2352x1568px. Fundus photo. 45° field of view
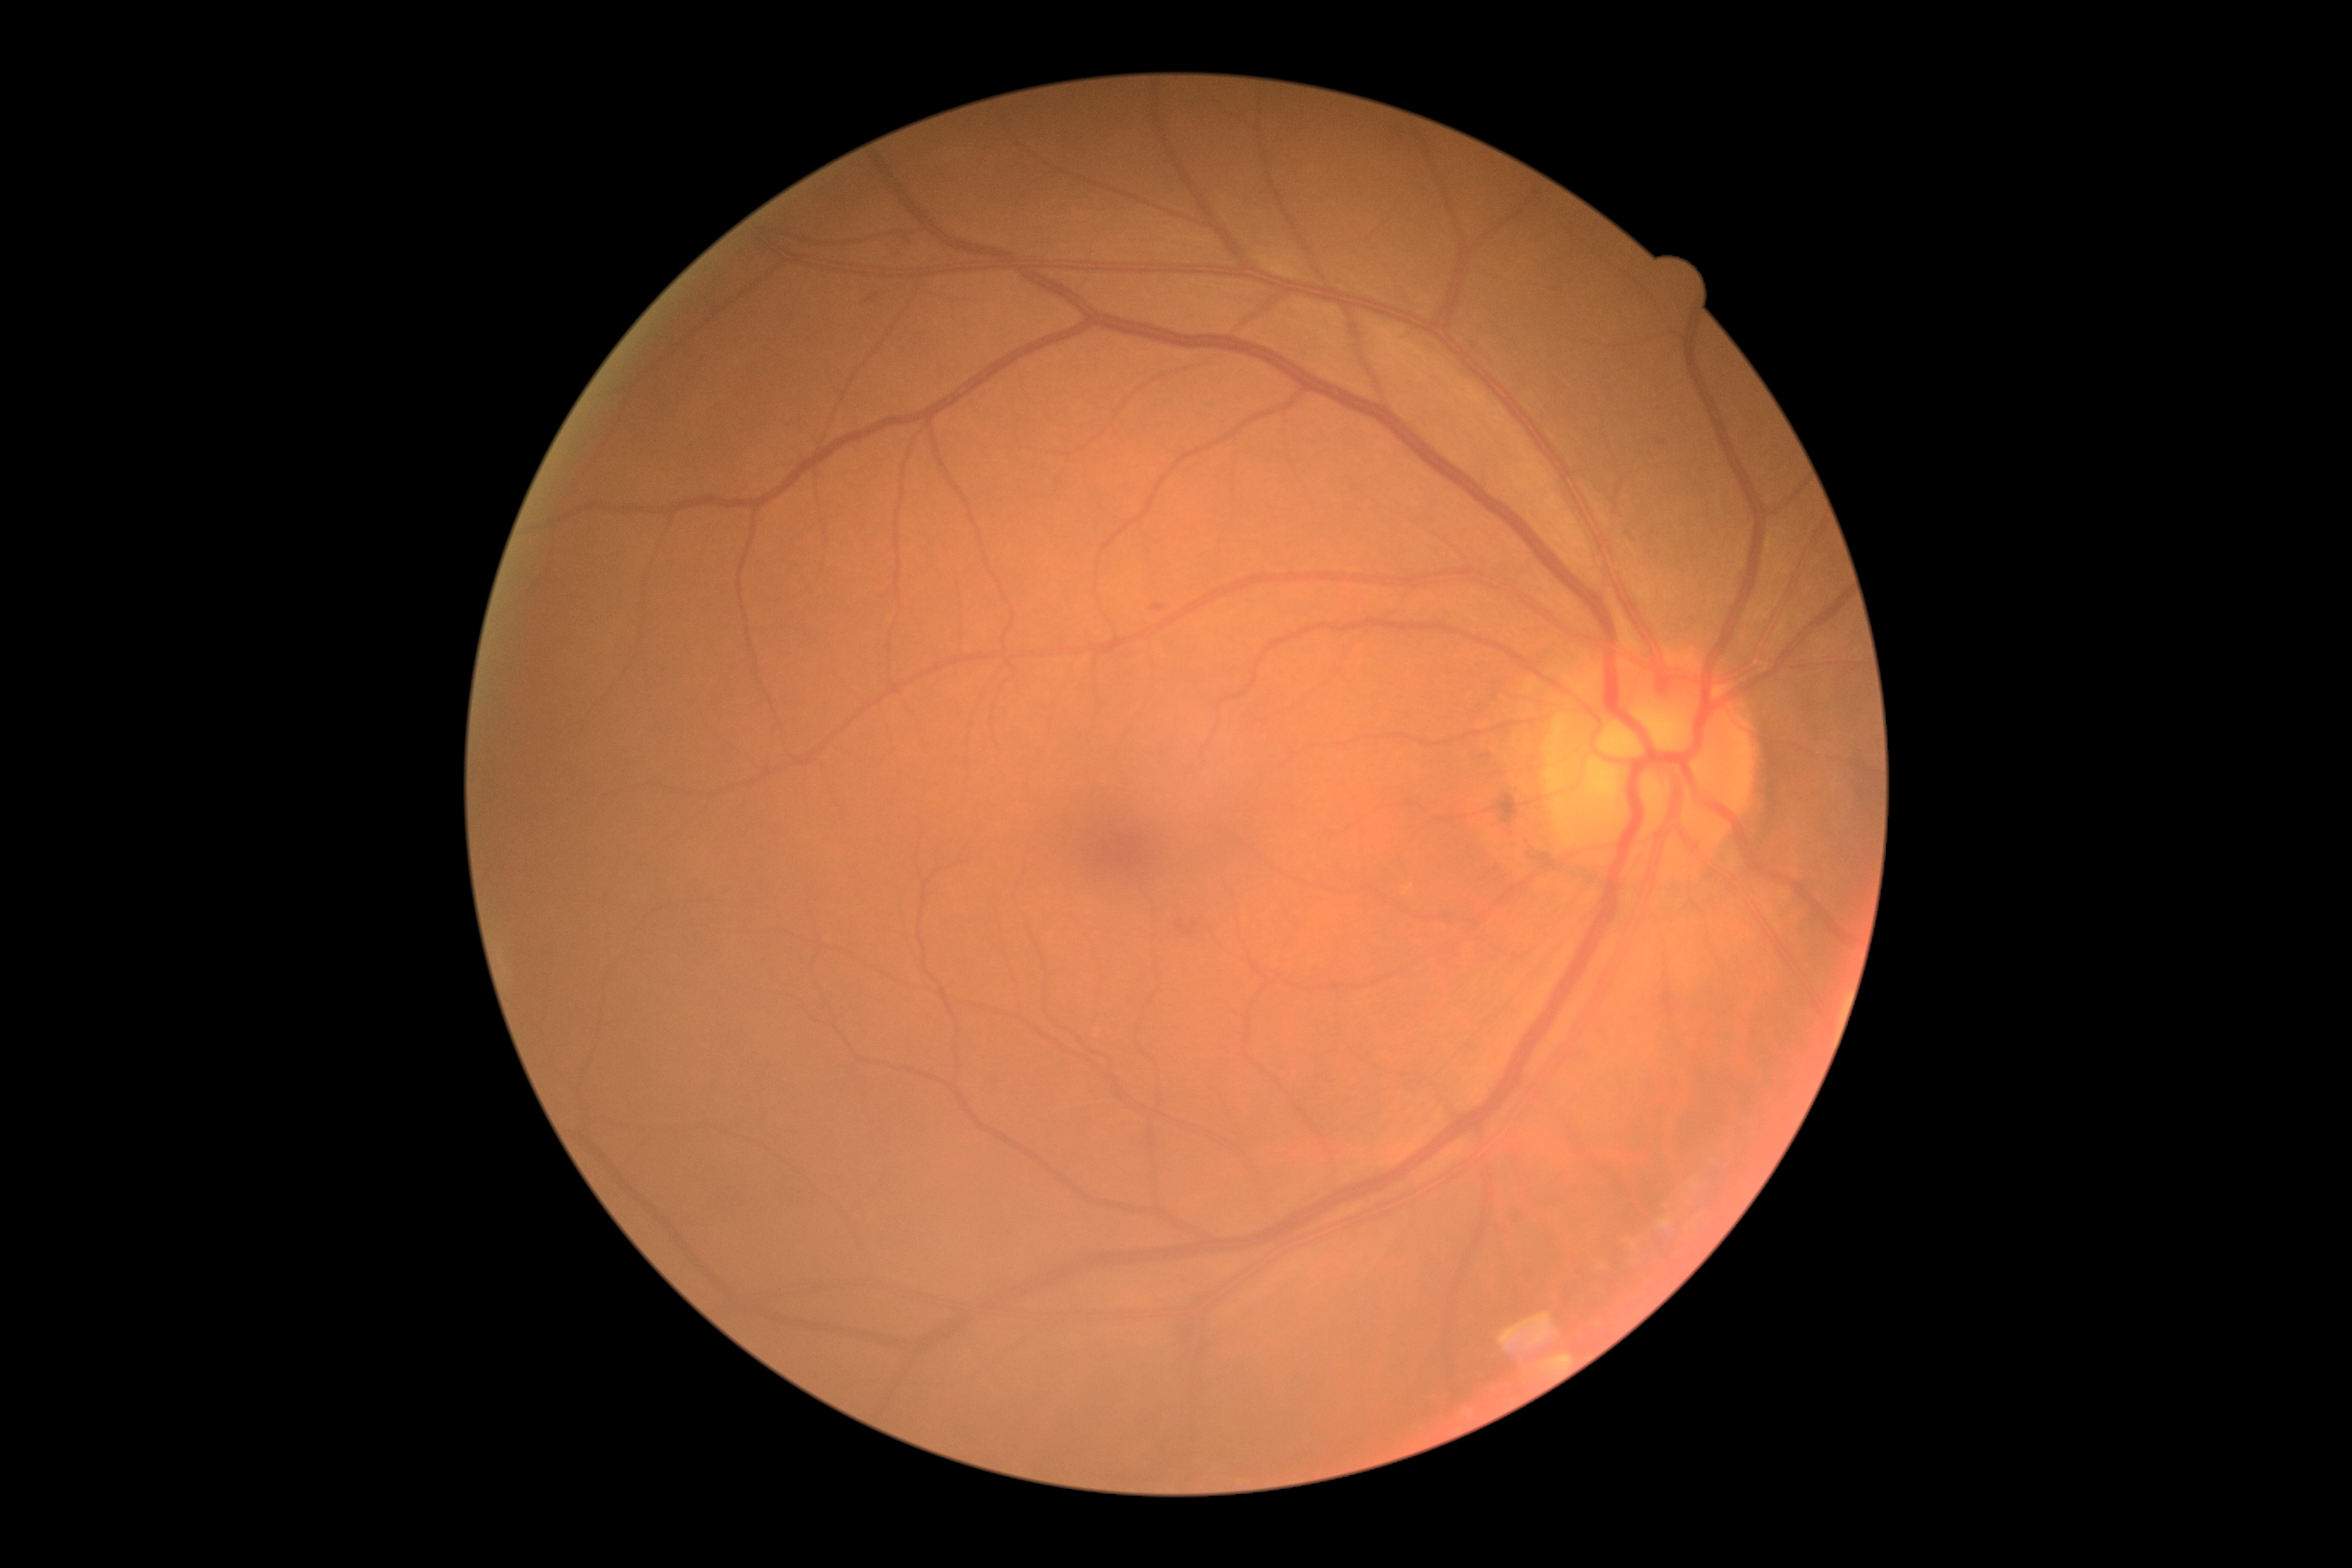 DR class: non-proliferative diabetic retinopathy.
Diabetic retinopathy severity: moderate non-proliferative diabetic retinopathy (grade 2).